Wide-field retinal mosaic image:
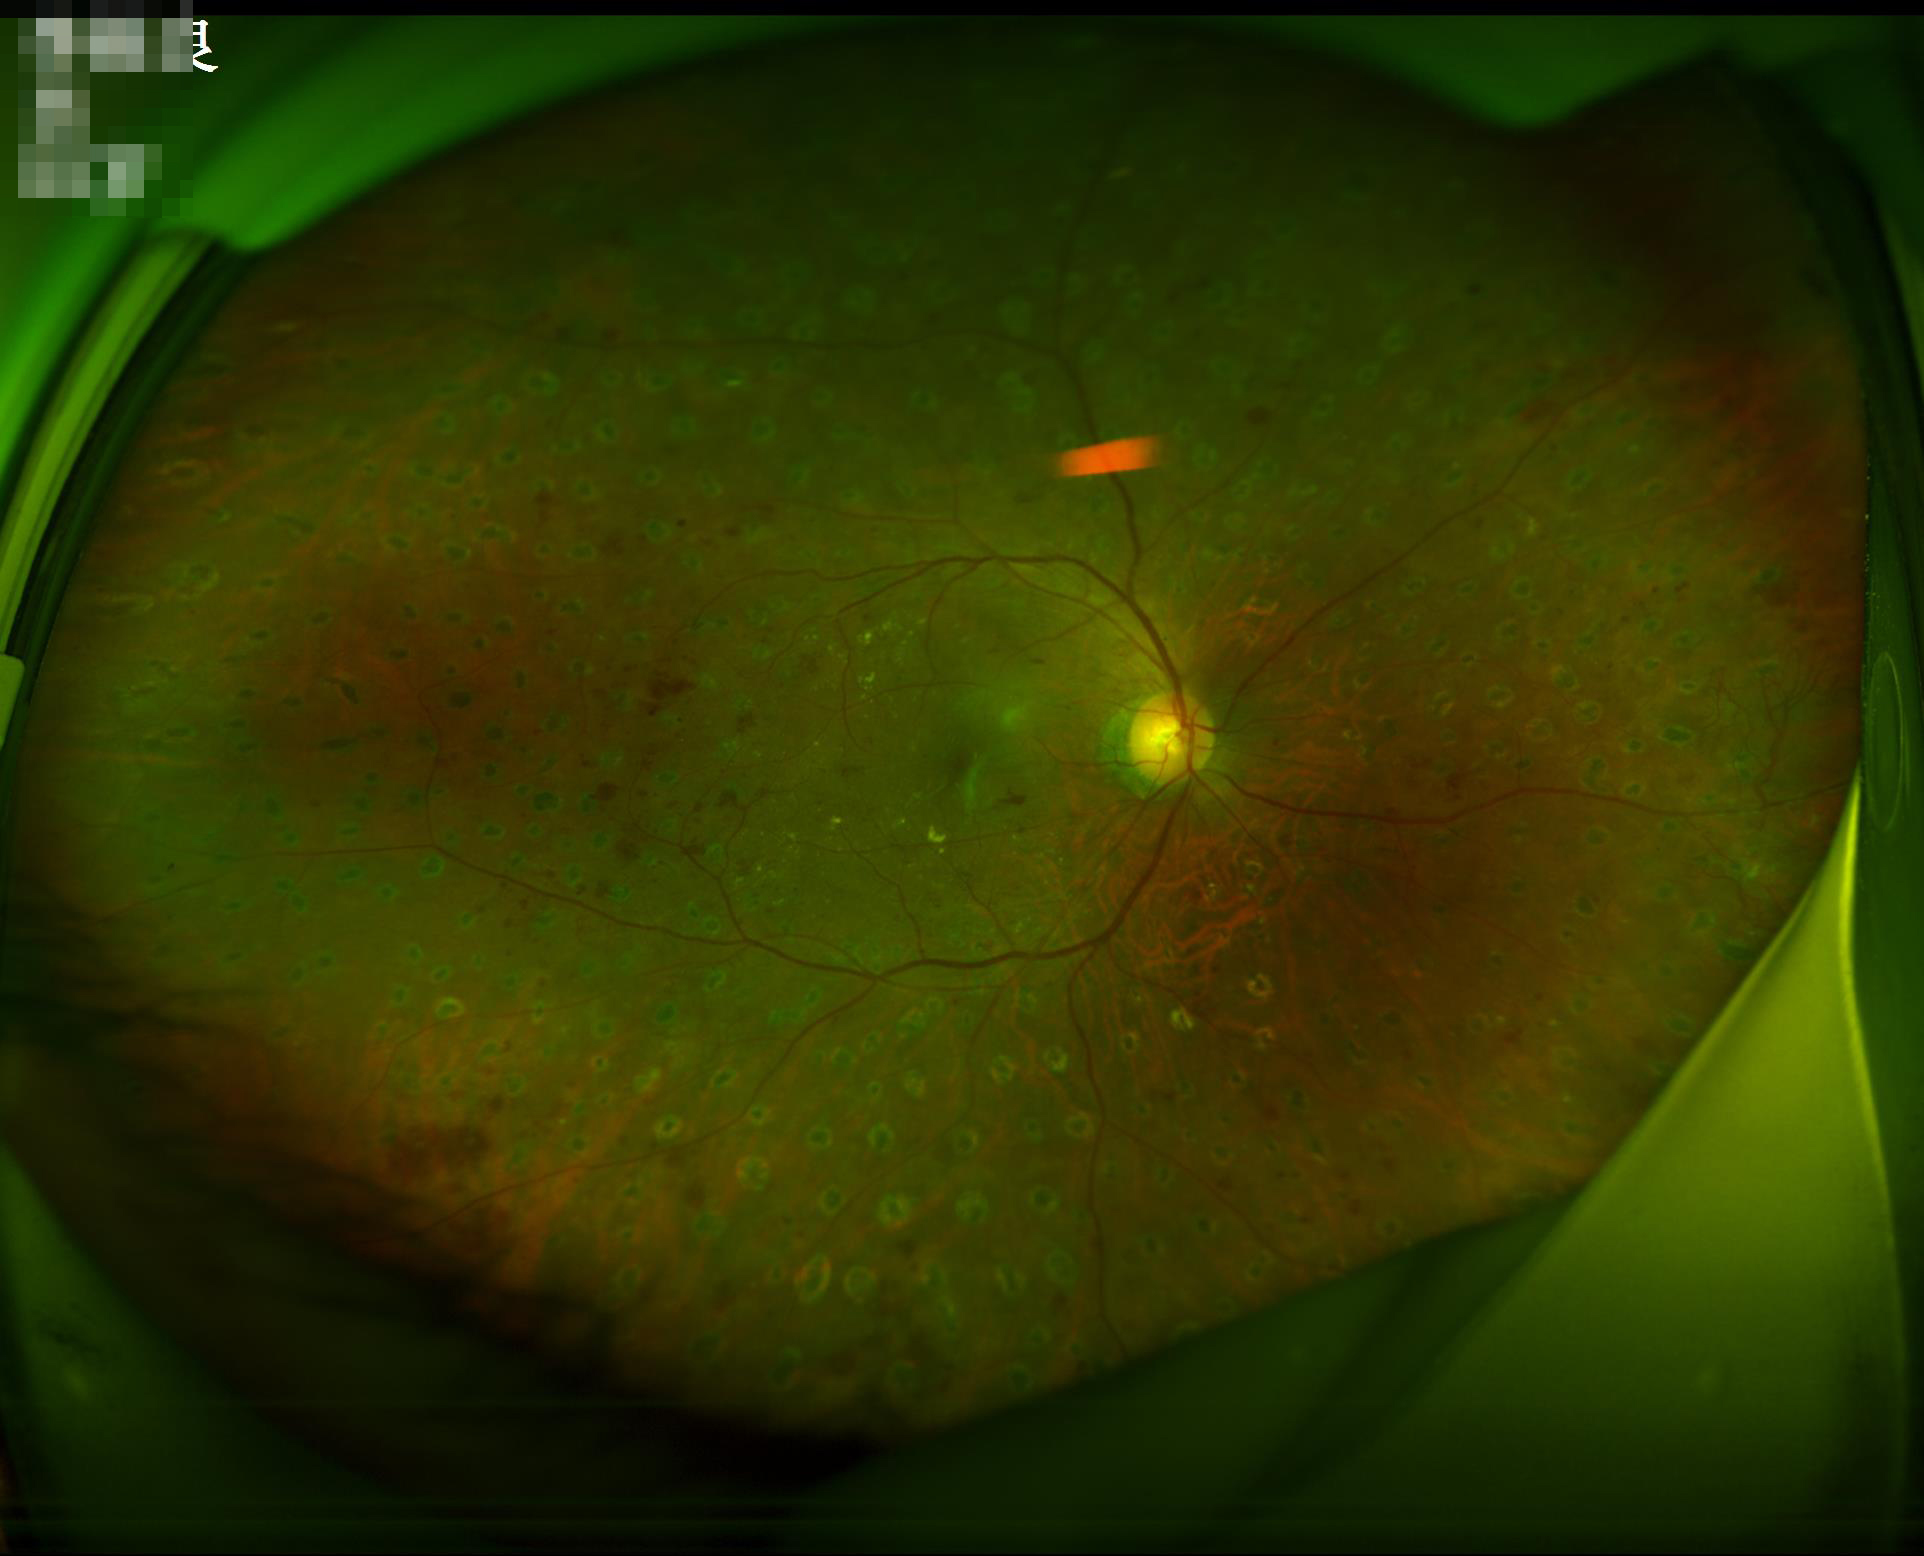 Overall quality is good and the image is gradable. Contrast is good. The image is clear.